Dilated-pupil acquisition.
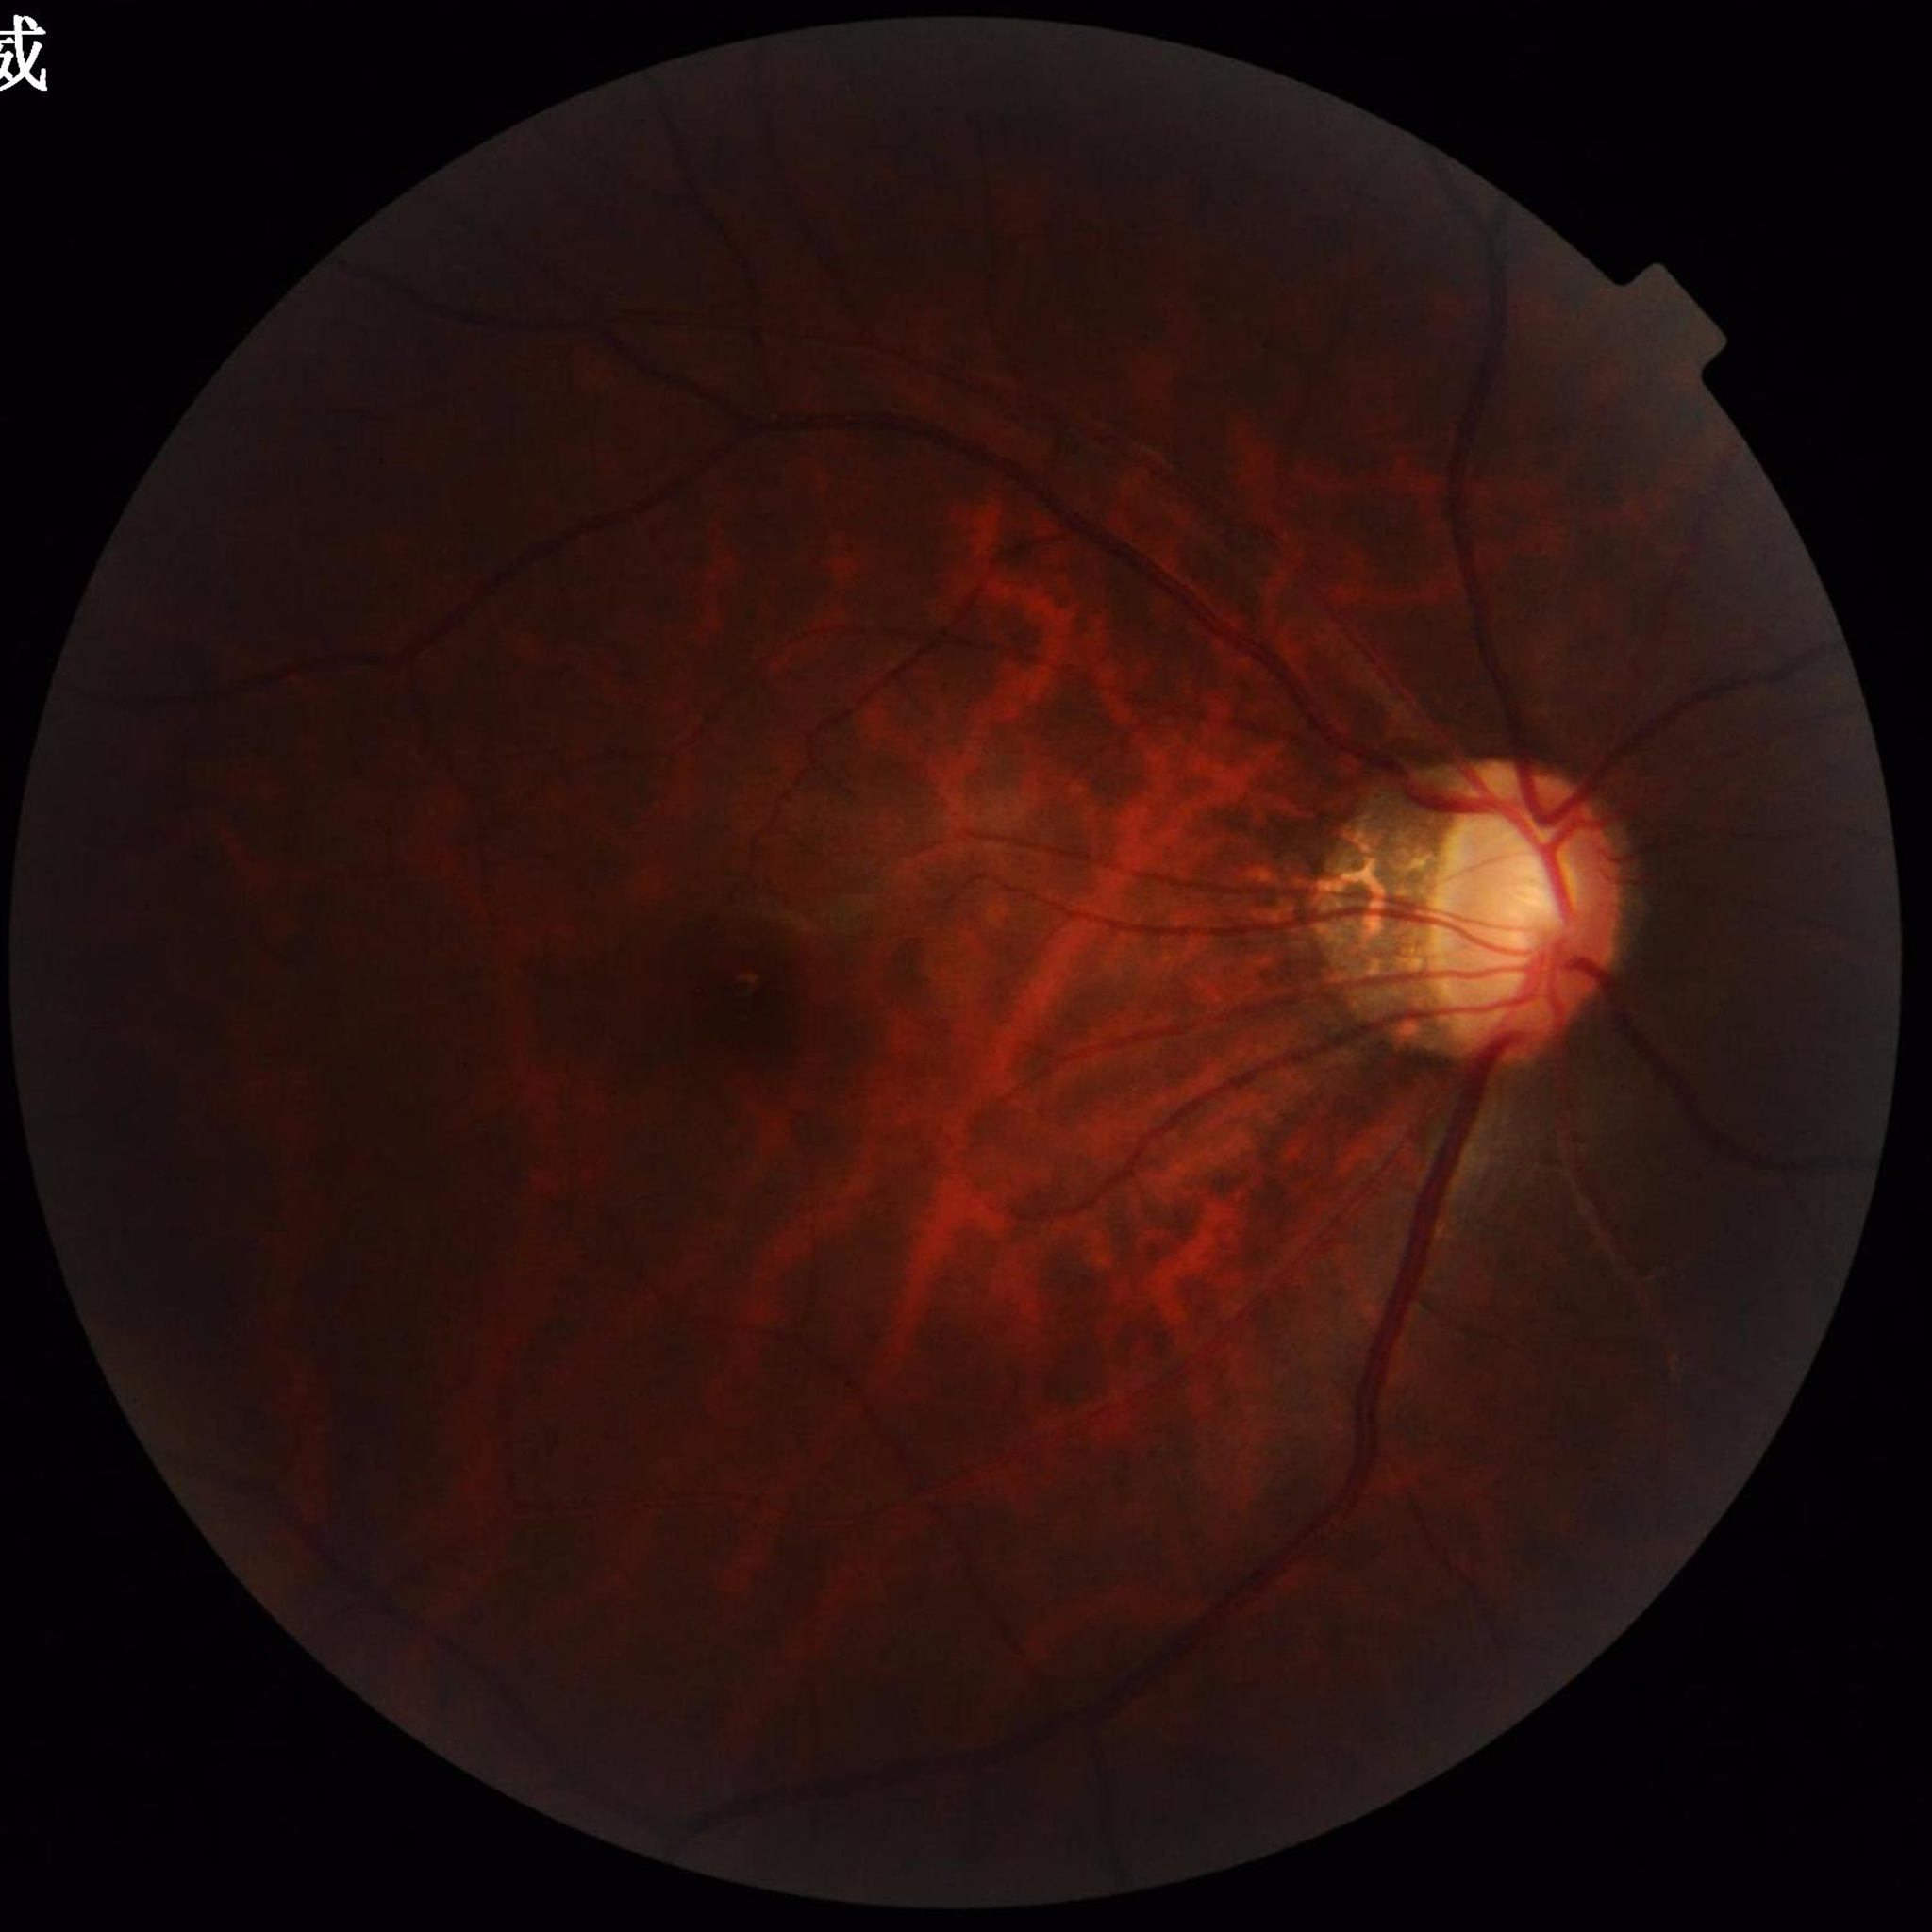

Clinical diagnosis = glaucoma
Image quality = issues noted — illumination/color distortion